1240x1240 · infant wide-field retinal image.
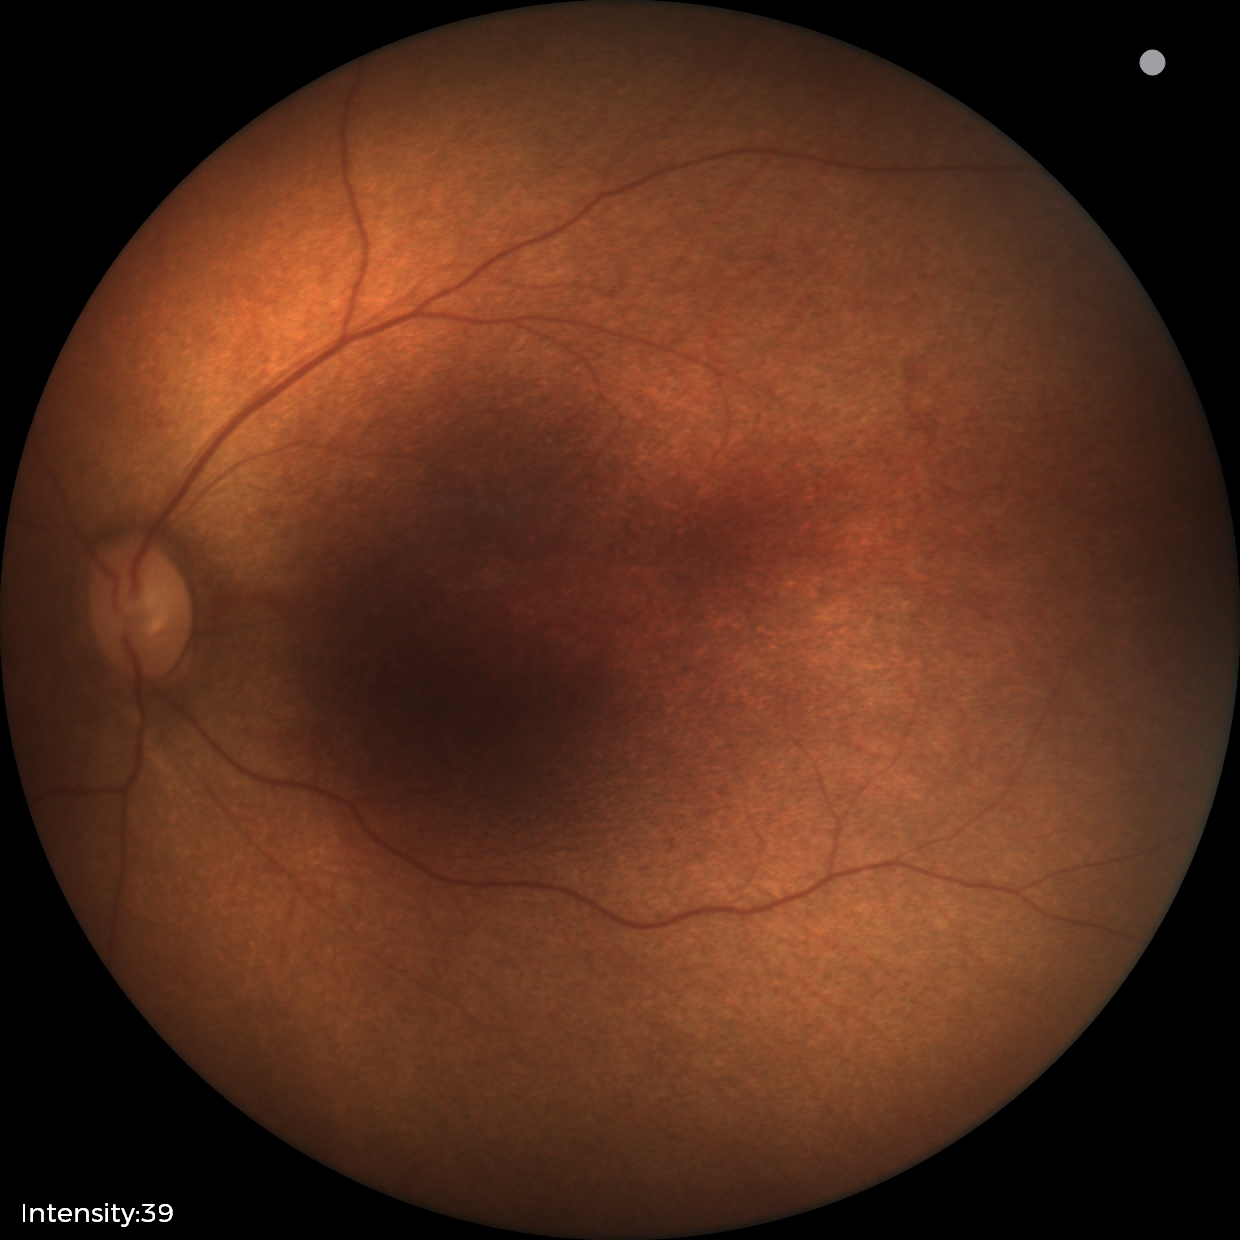 No retinal pathology identified on screening.